848 by 848 pixels; graded on the modified Davis scale; acquired with a NIDEK AFC-230; no pharmacologic dilation; color fundus image.
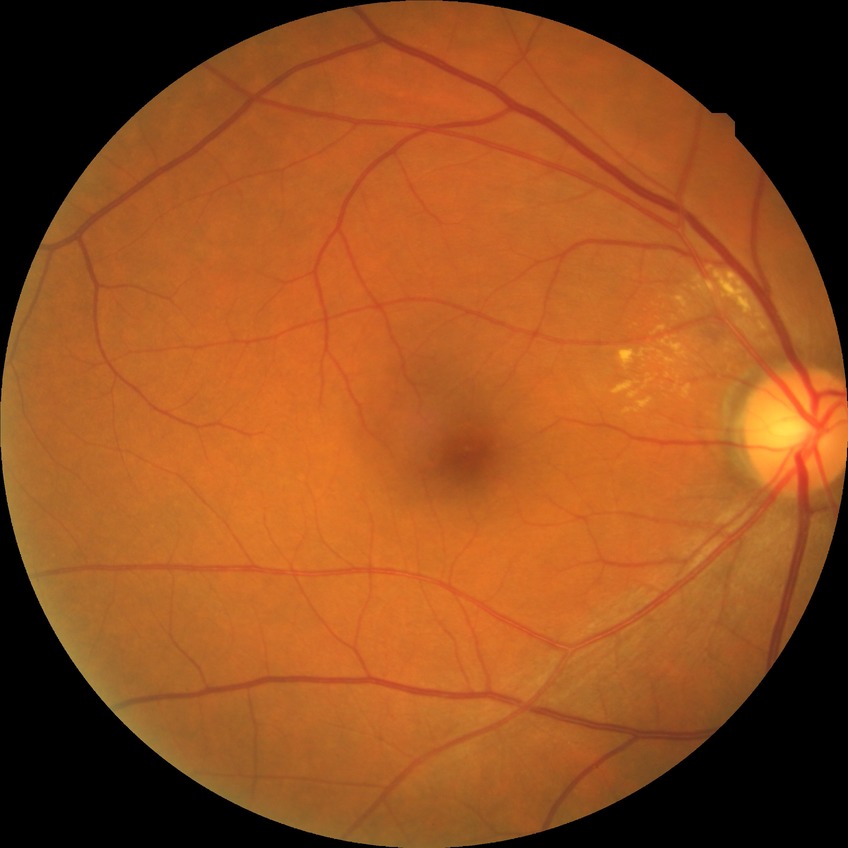
DR stage: SDR